45-degree field of view; modified Davis classification; posterior pole color fundus photograph
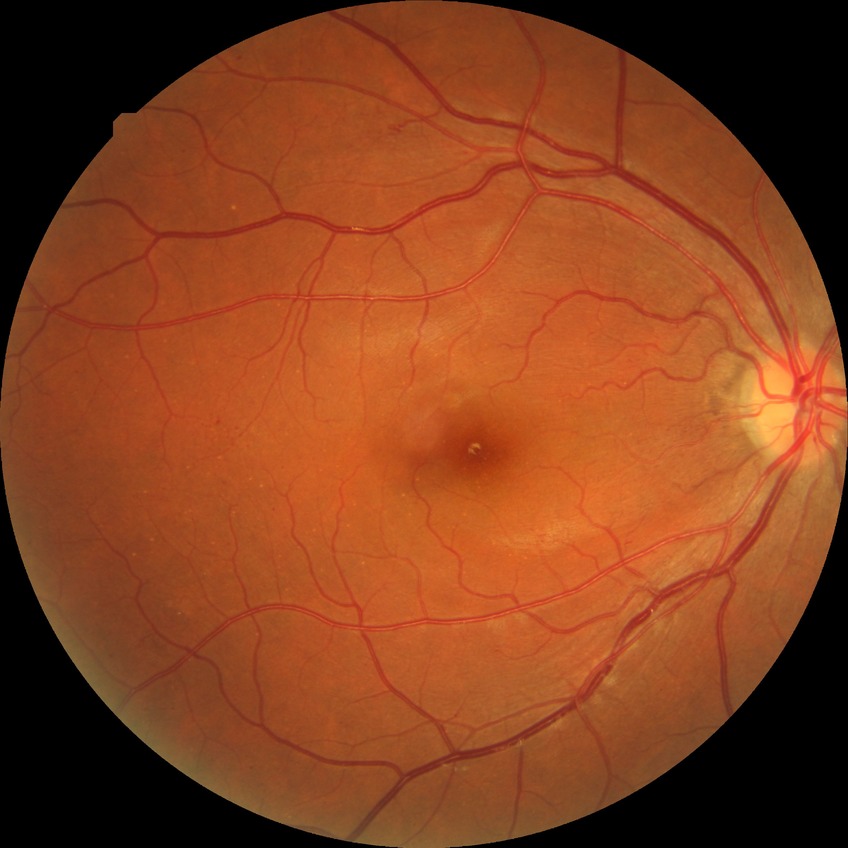

diabetic retinopathy severity@simple diabetic retinopathy.